640 x 480 pixels; infant wide-field retinal image — 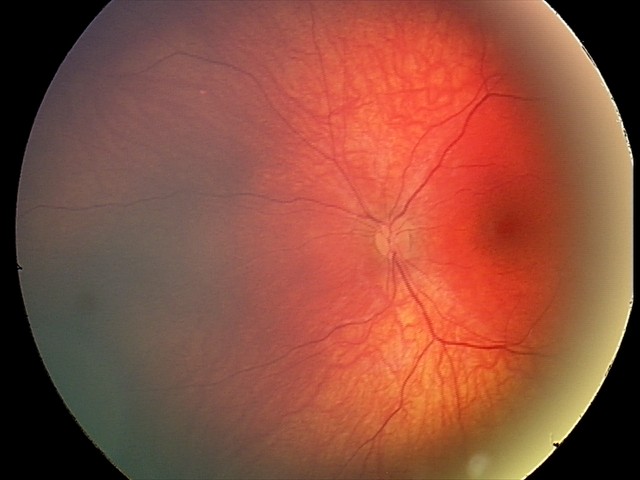 Screening diagnosis = retinal astrocytic hamartoma